2184 x 1690 pixels, color fundus photograph, 45° FOV: 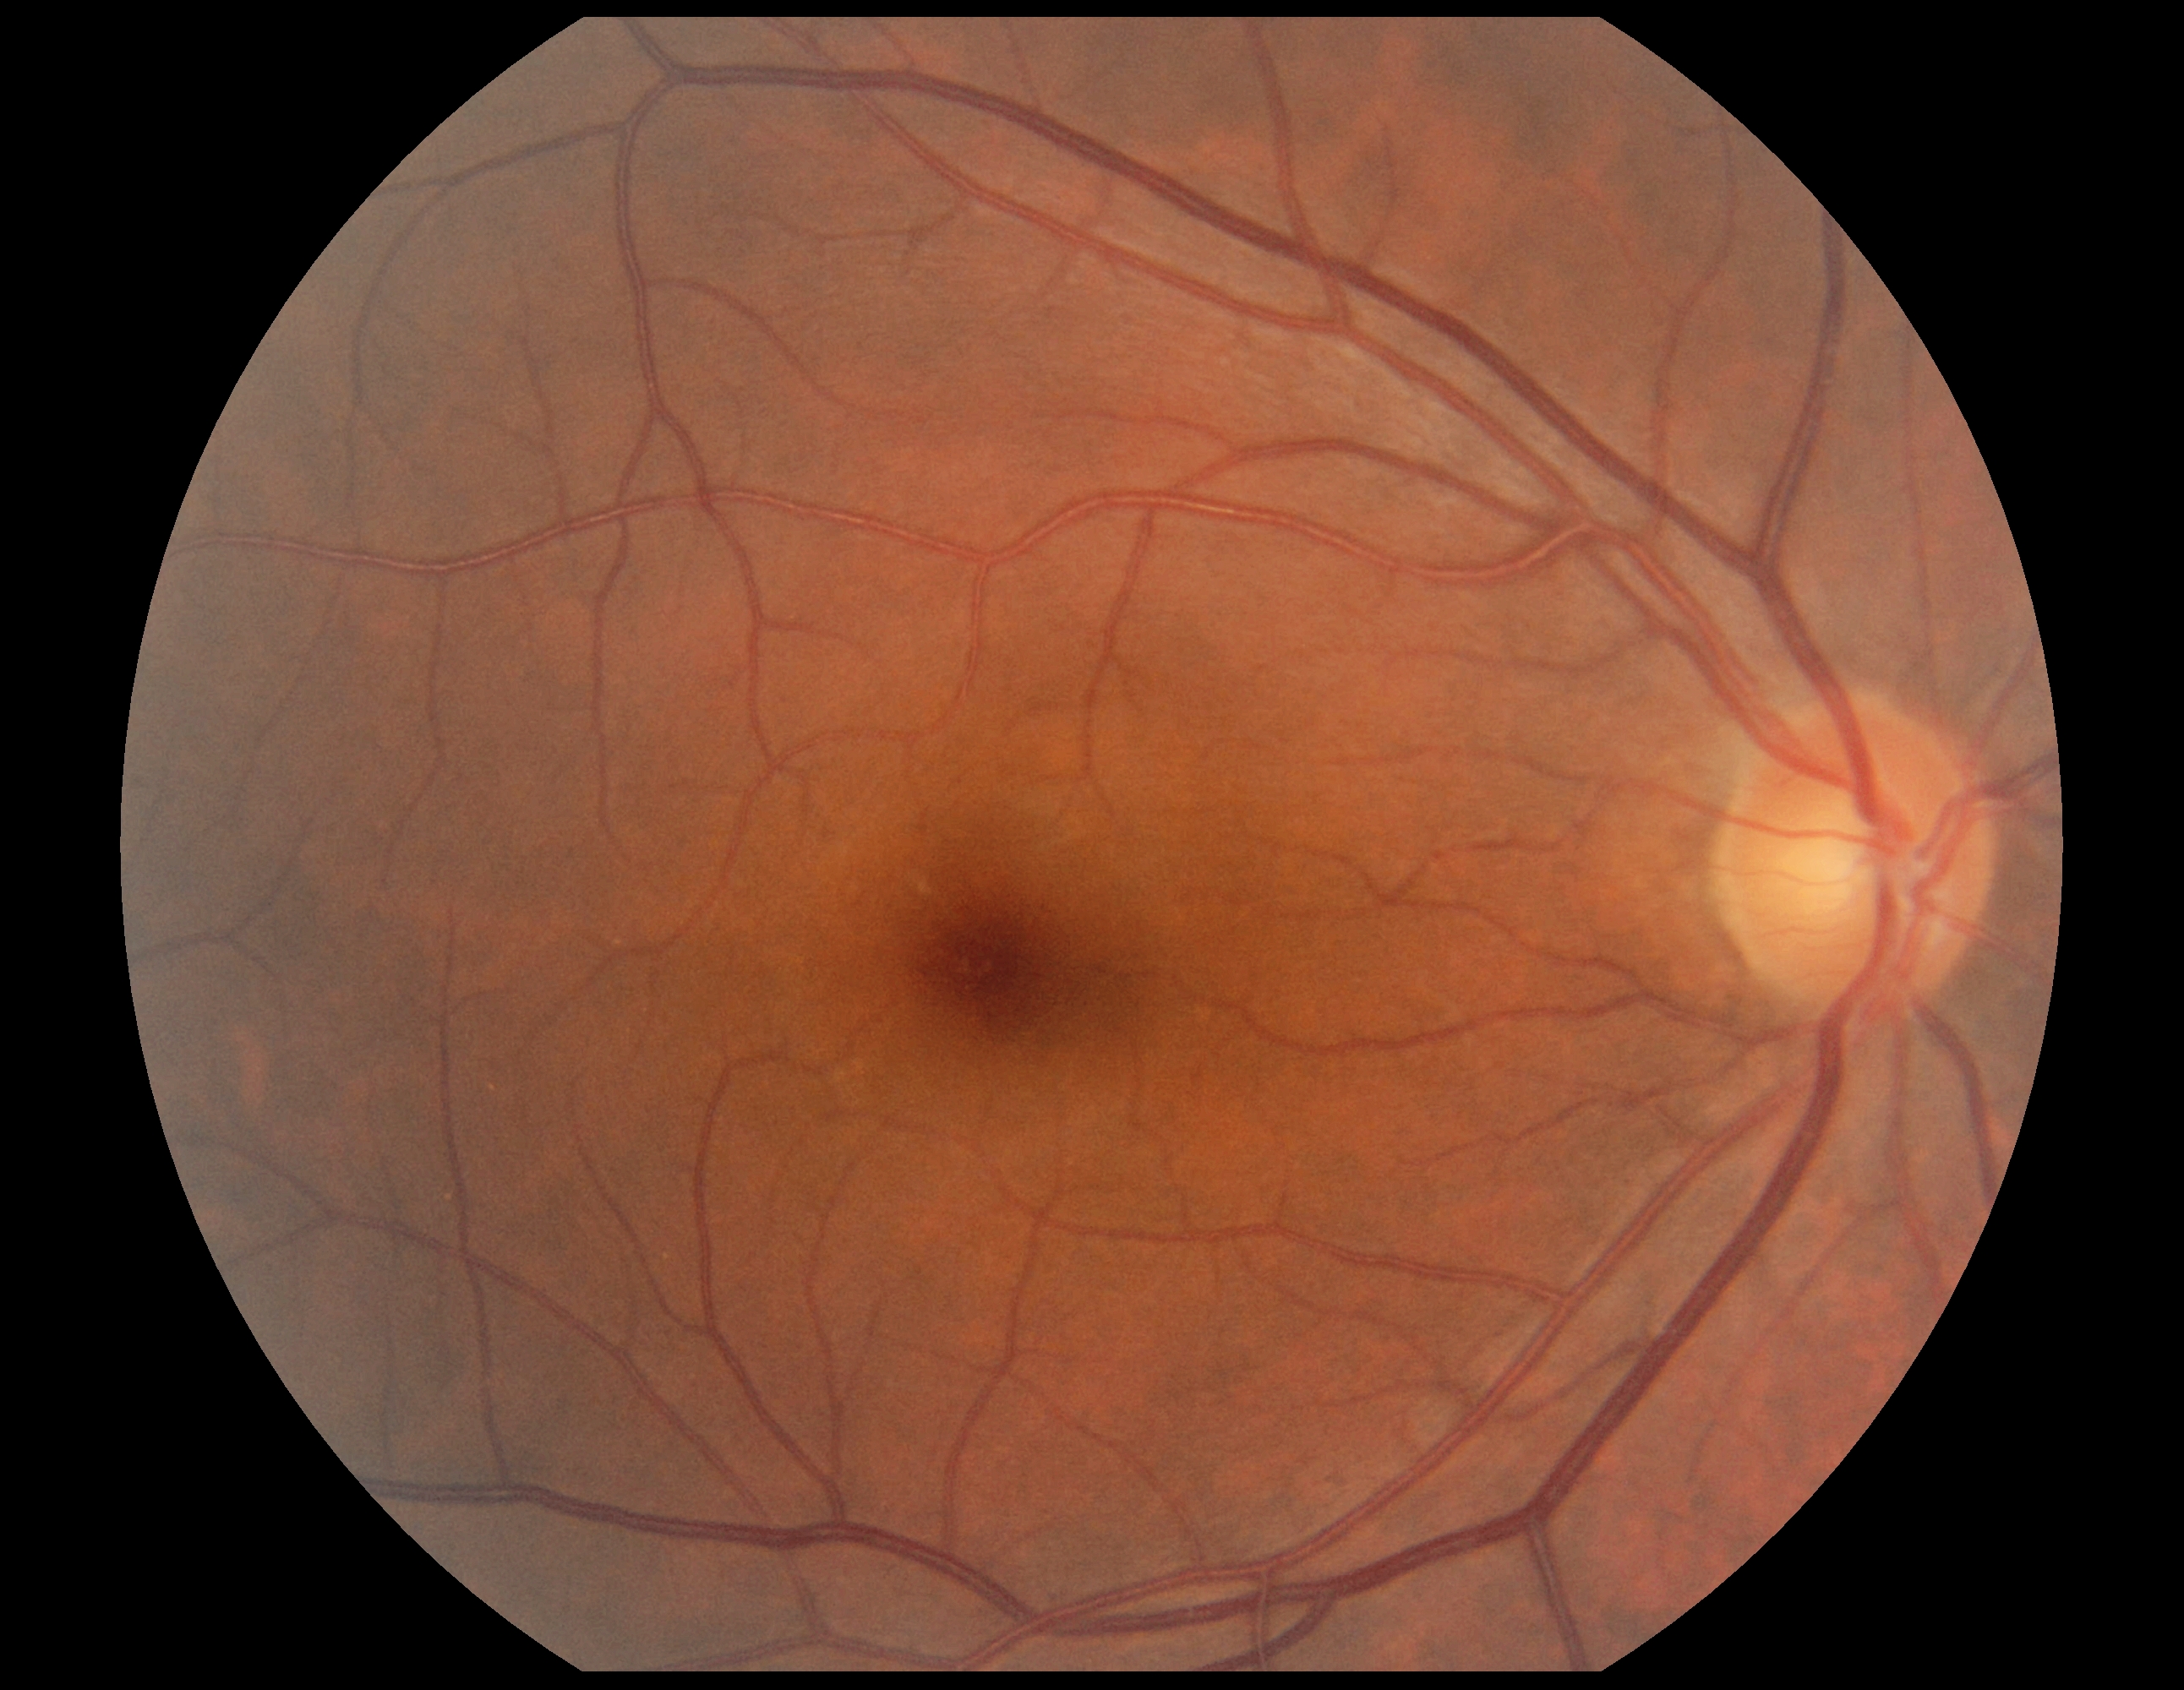   dr_grade: no apparent retinopathy (grade 0)